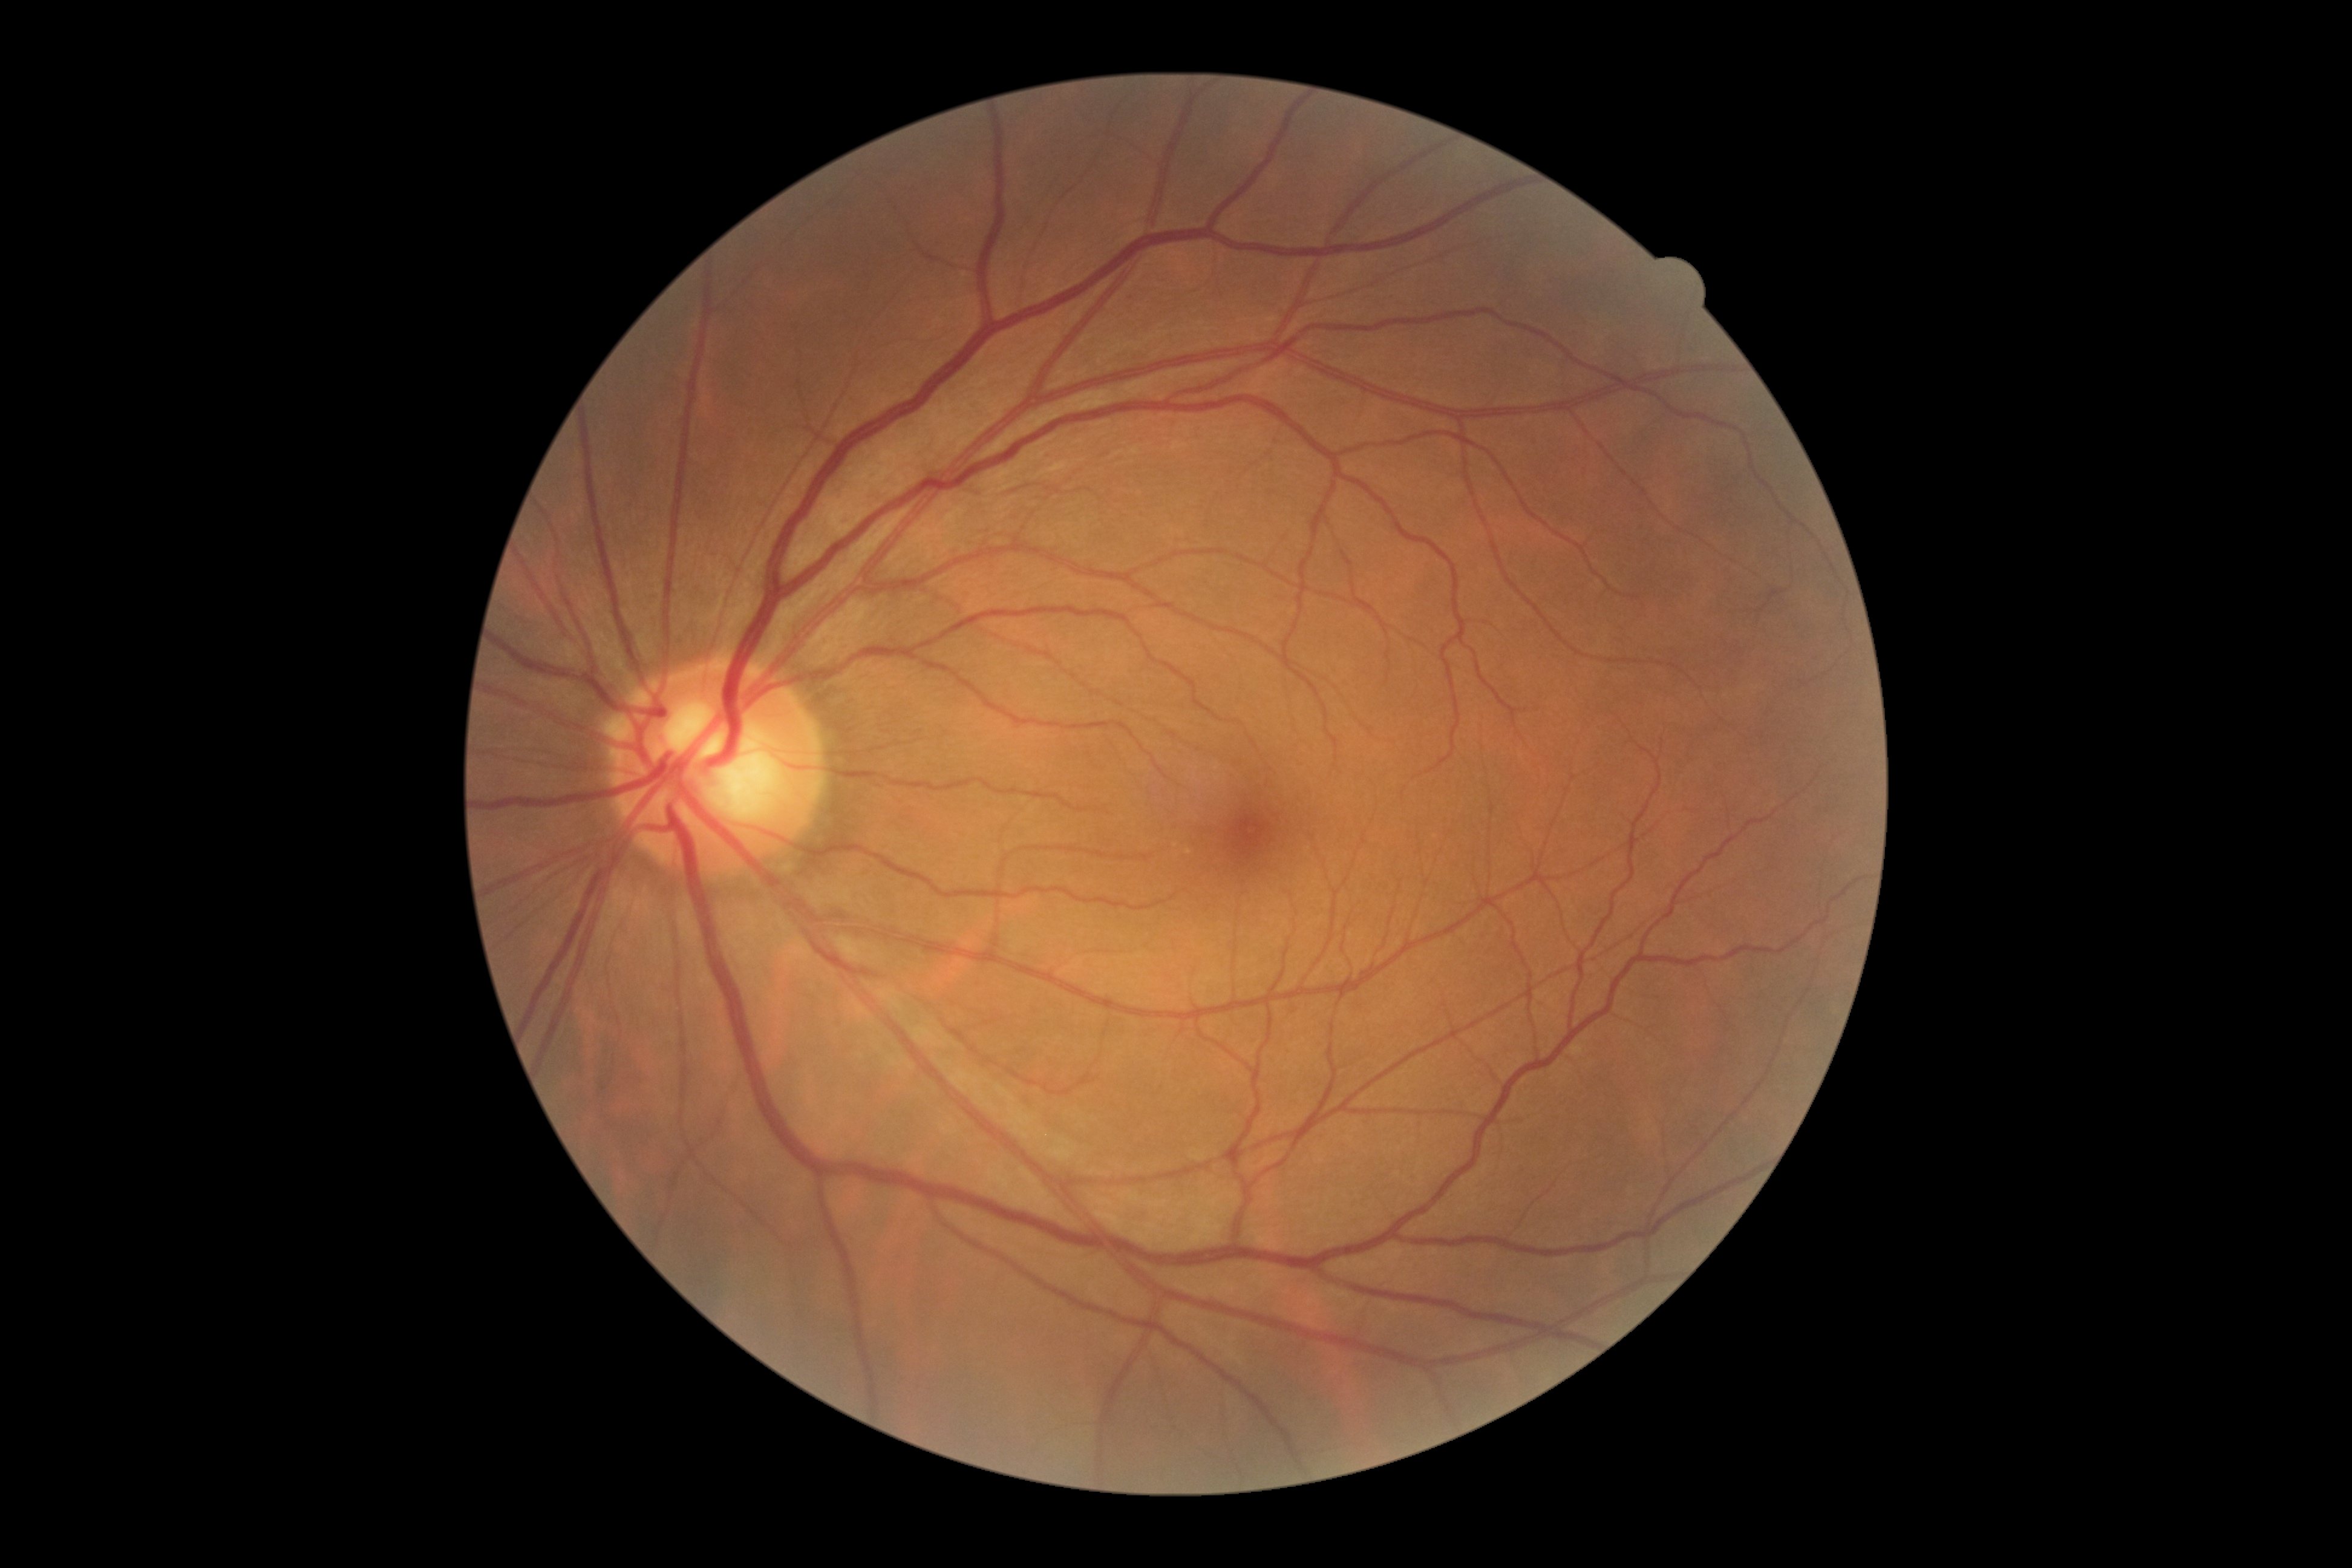 DR stage is 0/4. No DR findings.